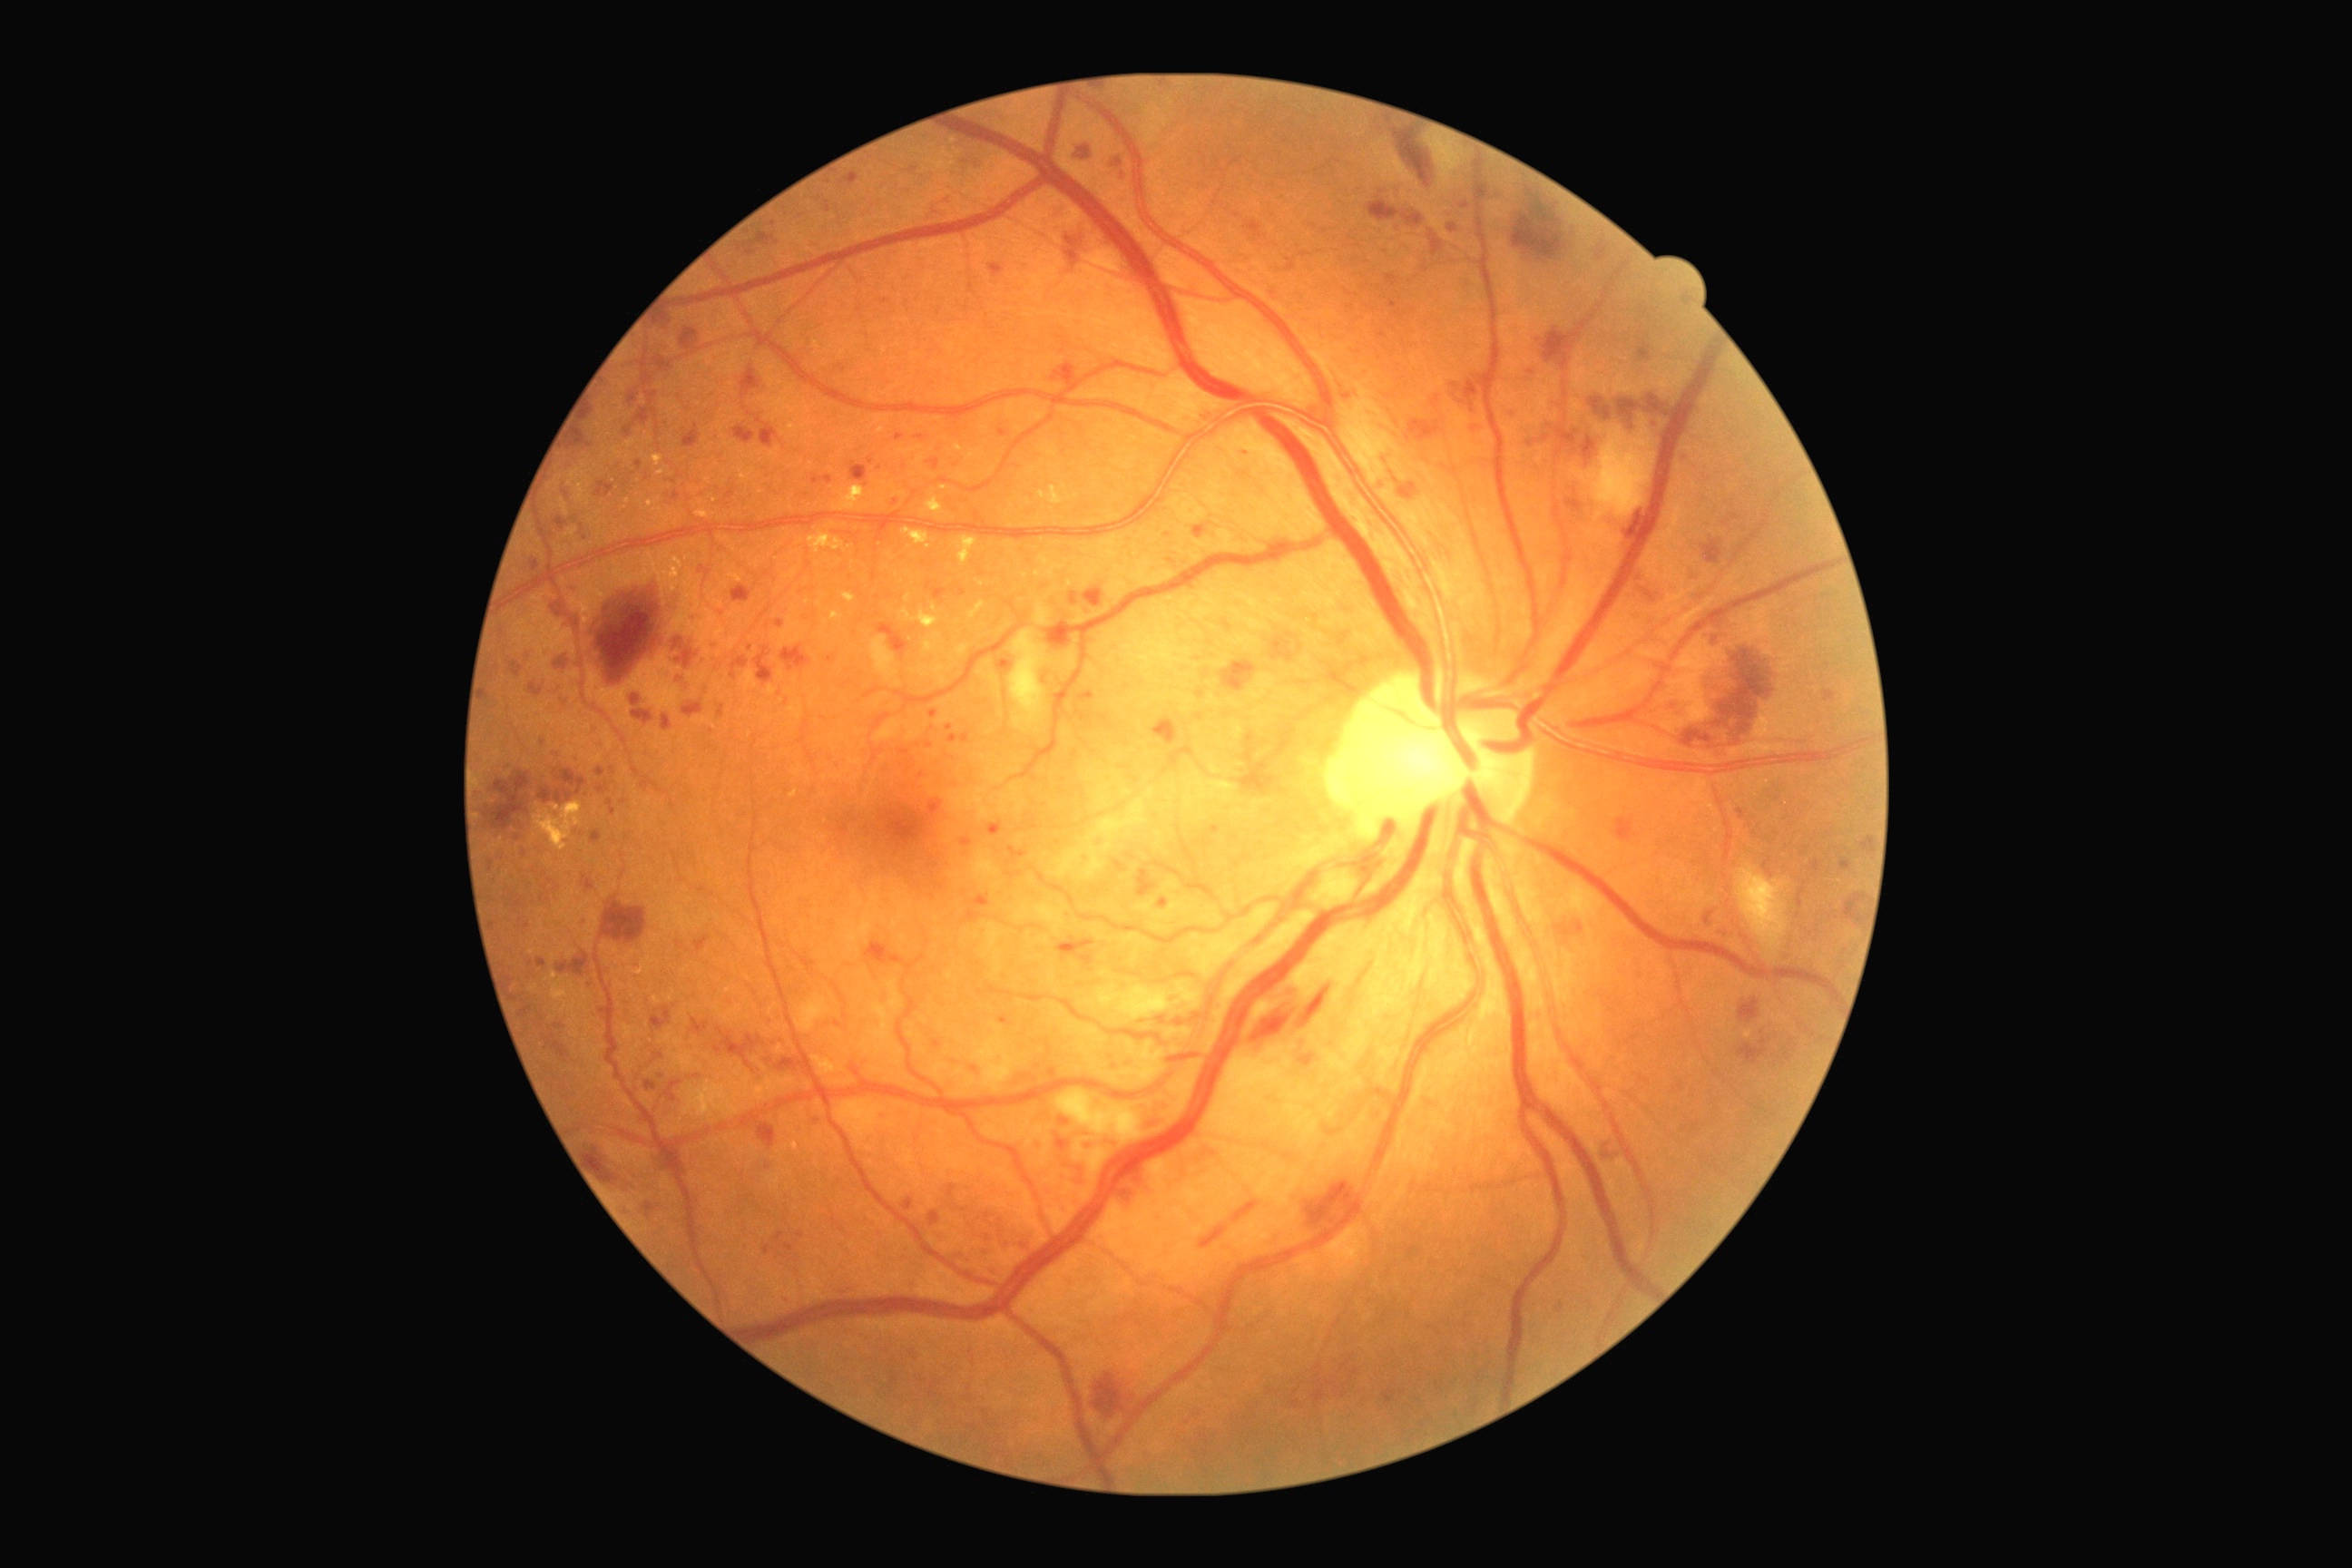 Retinopathy grade: 3 (severe NPDR).